Modified Davis grading — 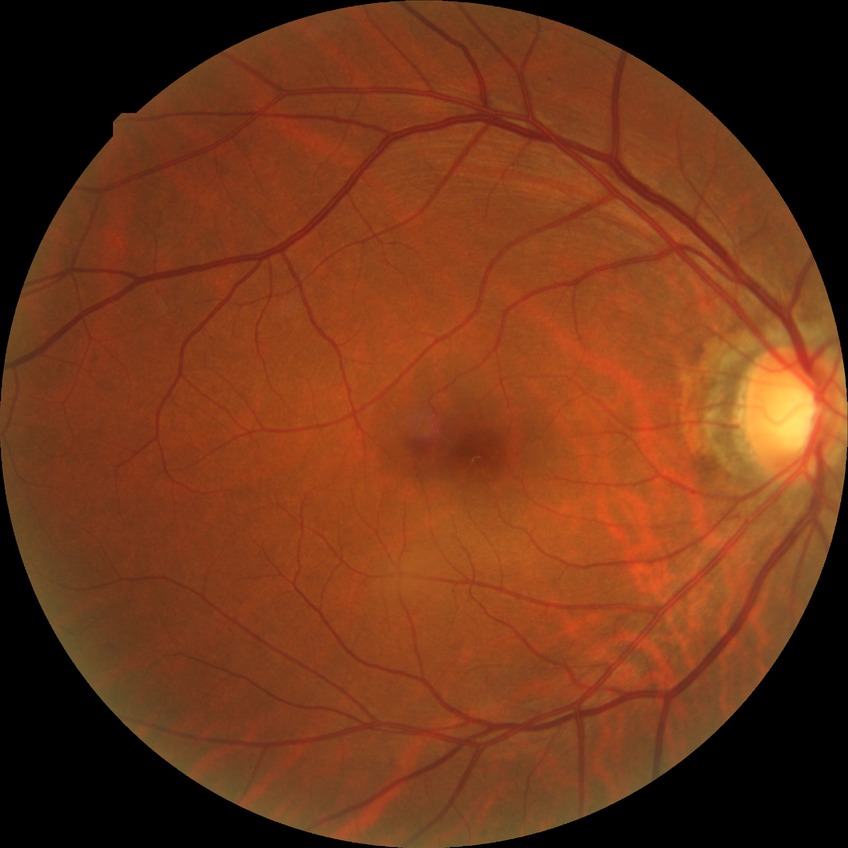 davis_grade: simple diabetic retinopathy